CFP.
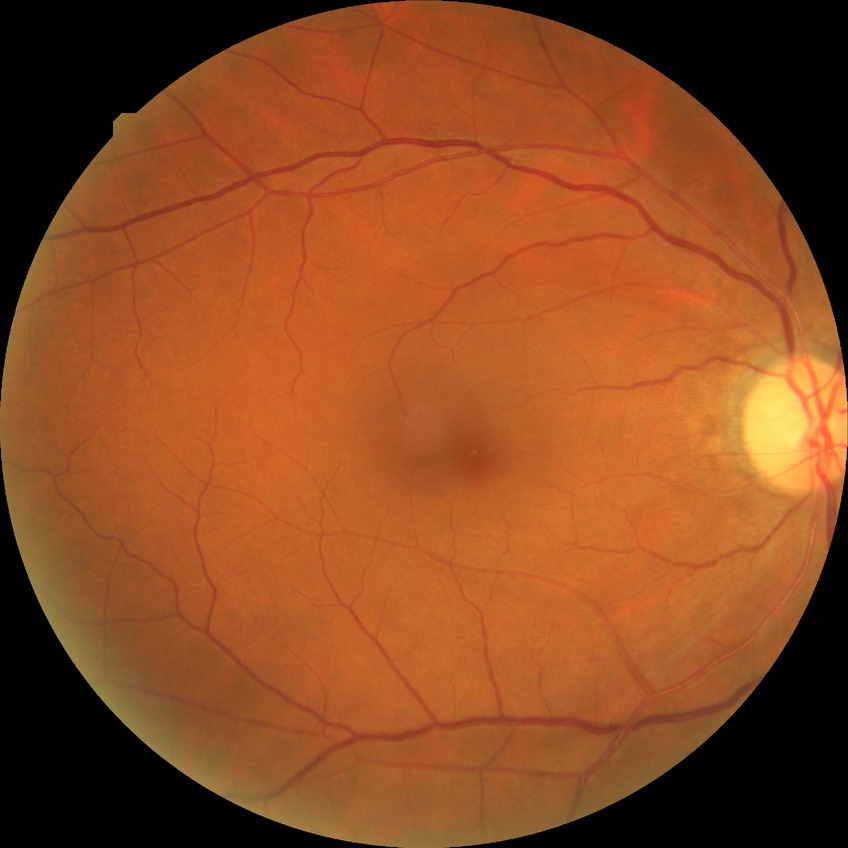
Findings:
• retinopathy stage — no diabetic retinopathy